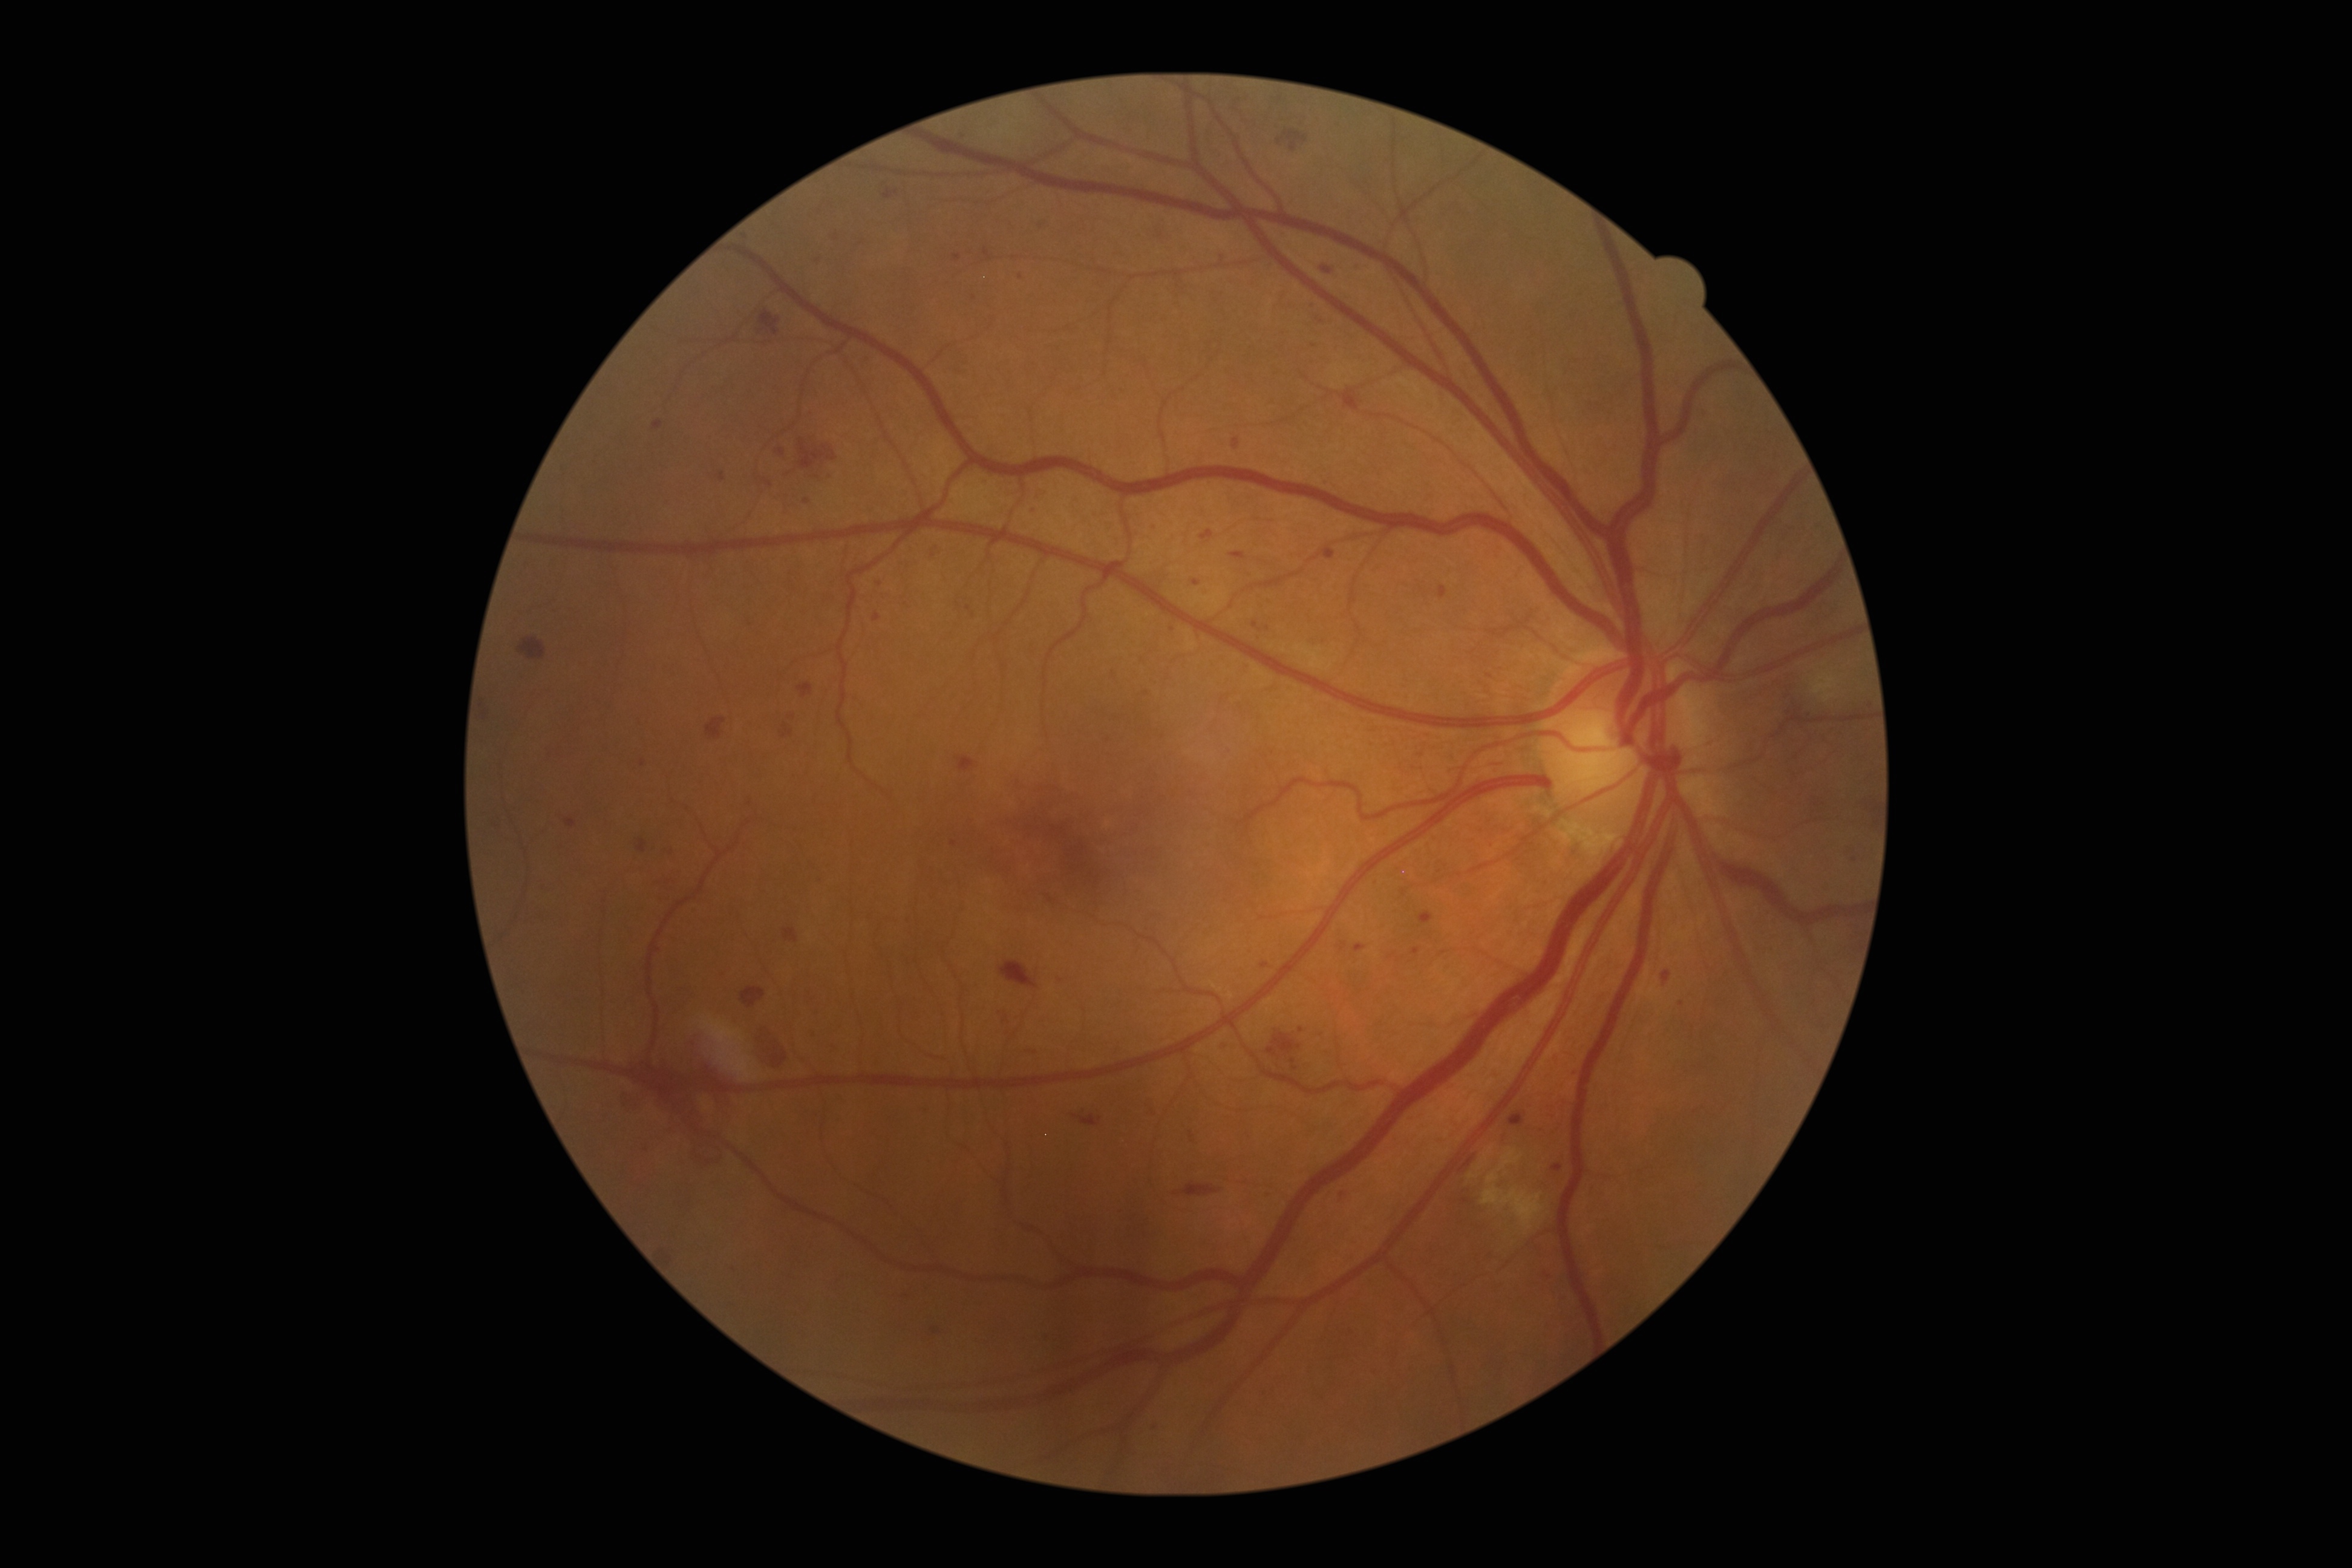
Retinopathy is grade 3
Representative lesions:
• microaneurysms (subset): bbox=(1322, 267, 1333, 275), bbox=(1413, 947, 1420, 955), bbox=(932, 546, 943, 558), bbox=(728, 1270, 736, 1278), bbox=(1027, 1052, 1036, 1057), bbox=(1201, 529, 1213, 541), bbox=(1509, 1112, 1525, 1126), bbox=(1543, 1275, 1552, 1287), bbox=(1261, 962, 1269, 969)
• Small microaneurysms approximately at [988,484], [1323,485], [1020,277], [1705,412], [749,803], [935,1330], [643,763], [1296,1068]